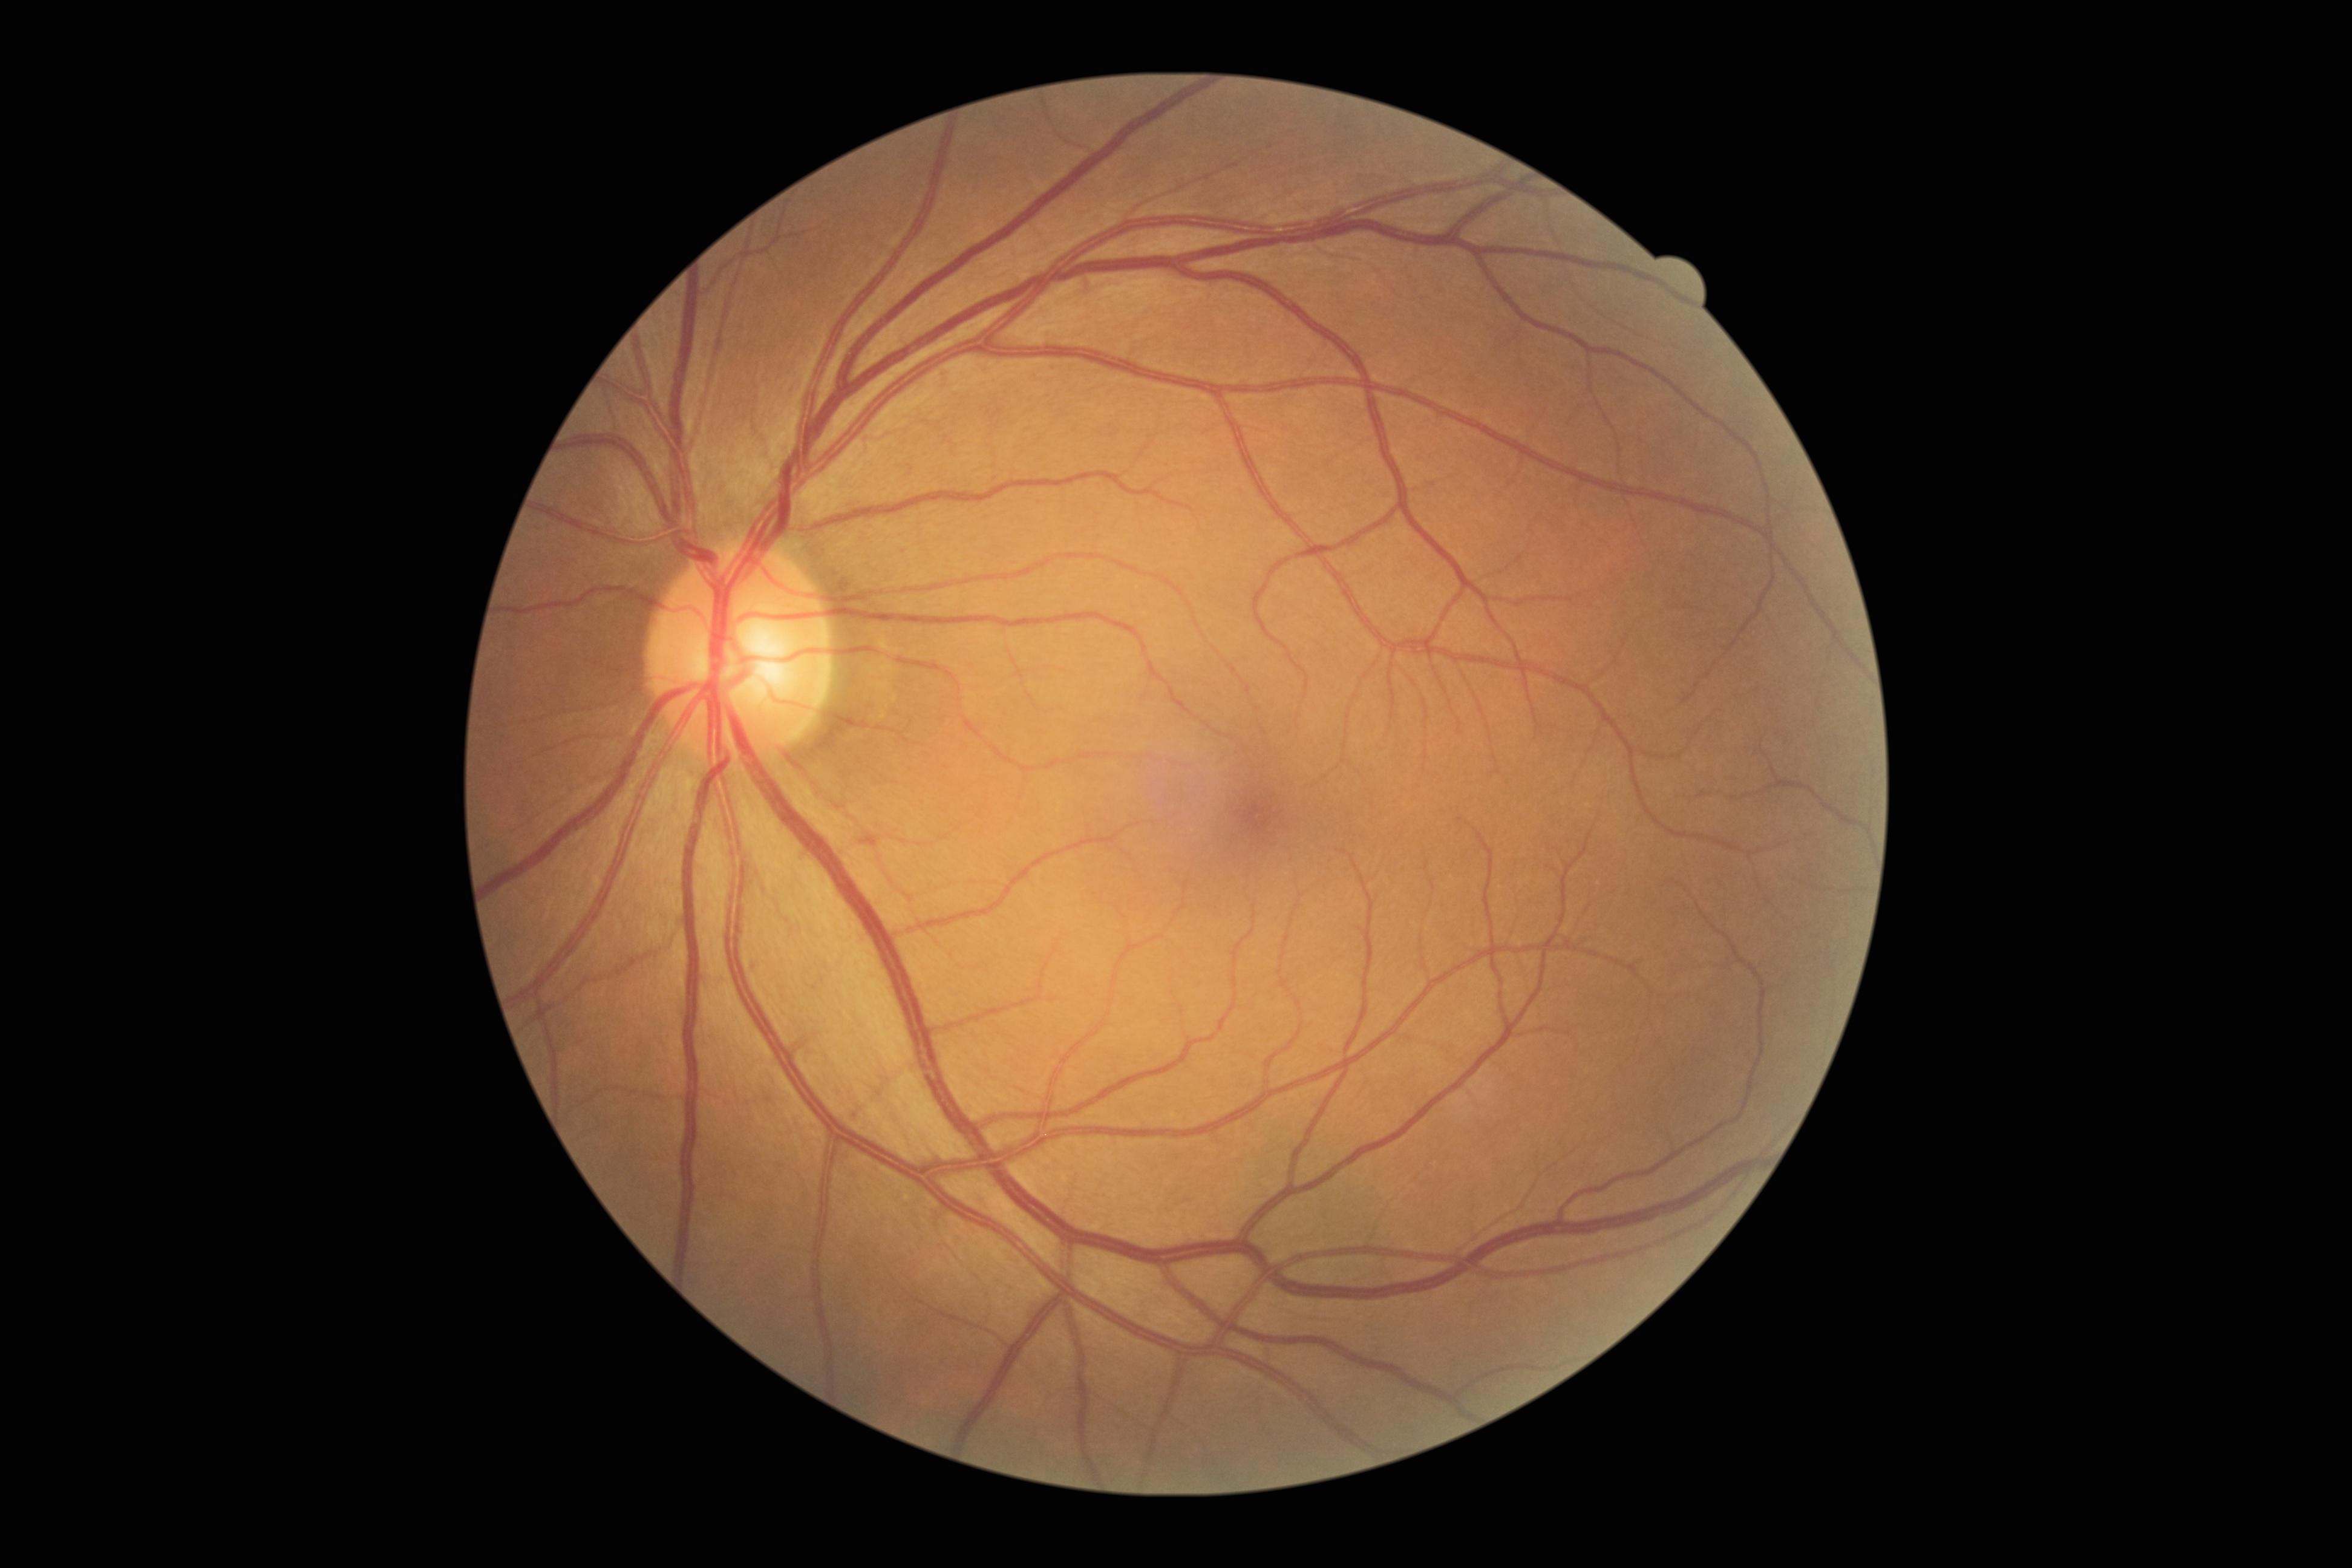
Diabetic retinopathy severity: no apparent diabetic retinopathy (grade 0) — no visible signs of diabetic retinopathy.